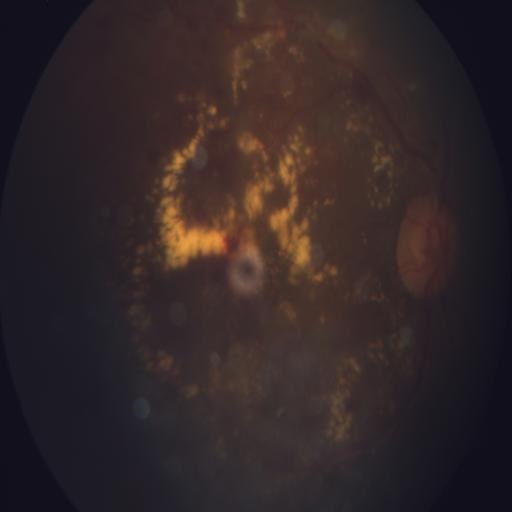 Two findings. This fundus photograph shows HR (hemorrhagic retinopathy) & EDN (exudation).